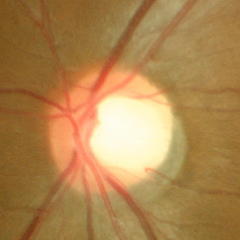
Fundus appearance consistent with no evidence of glaucoma.